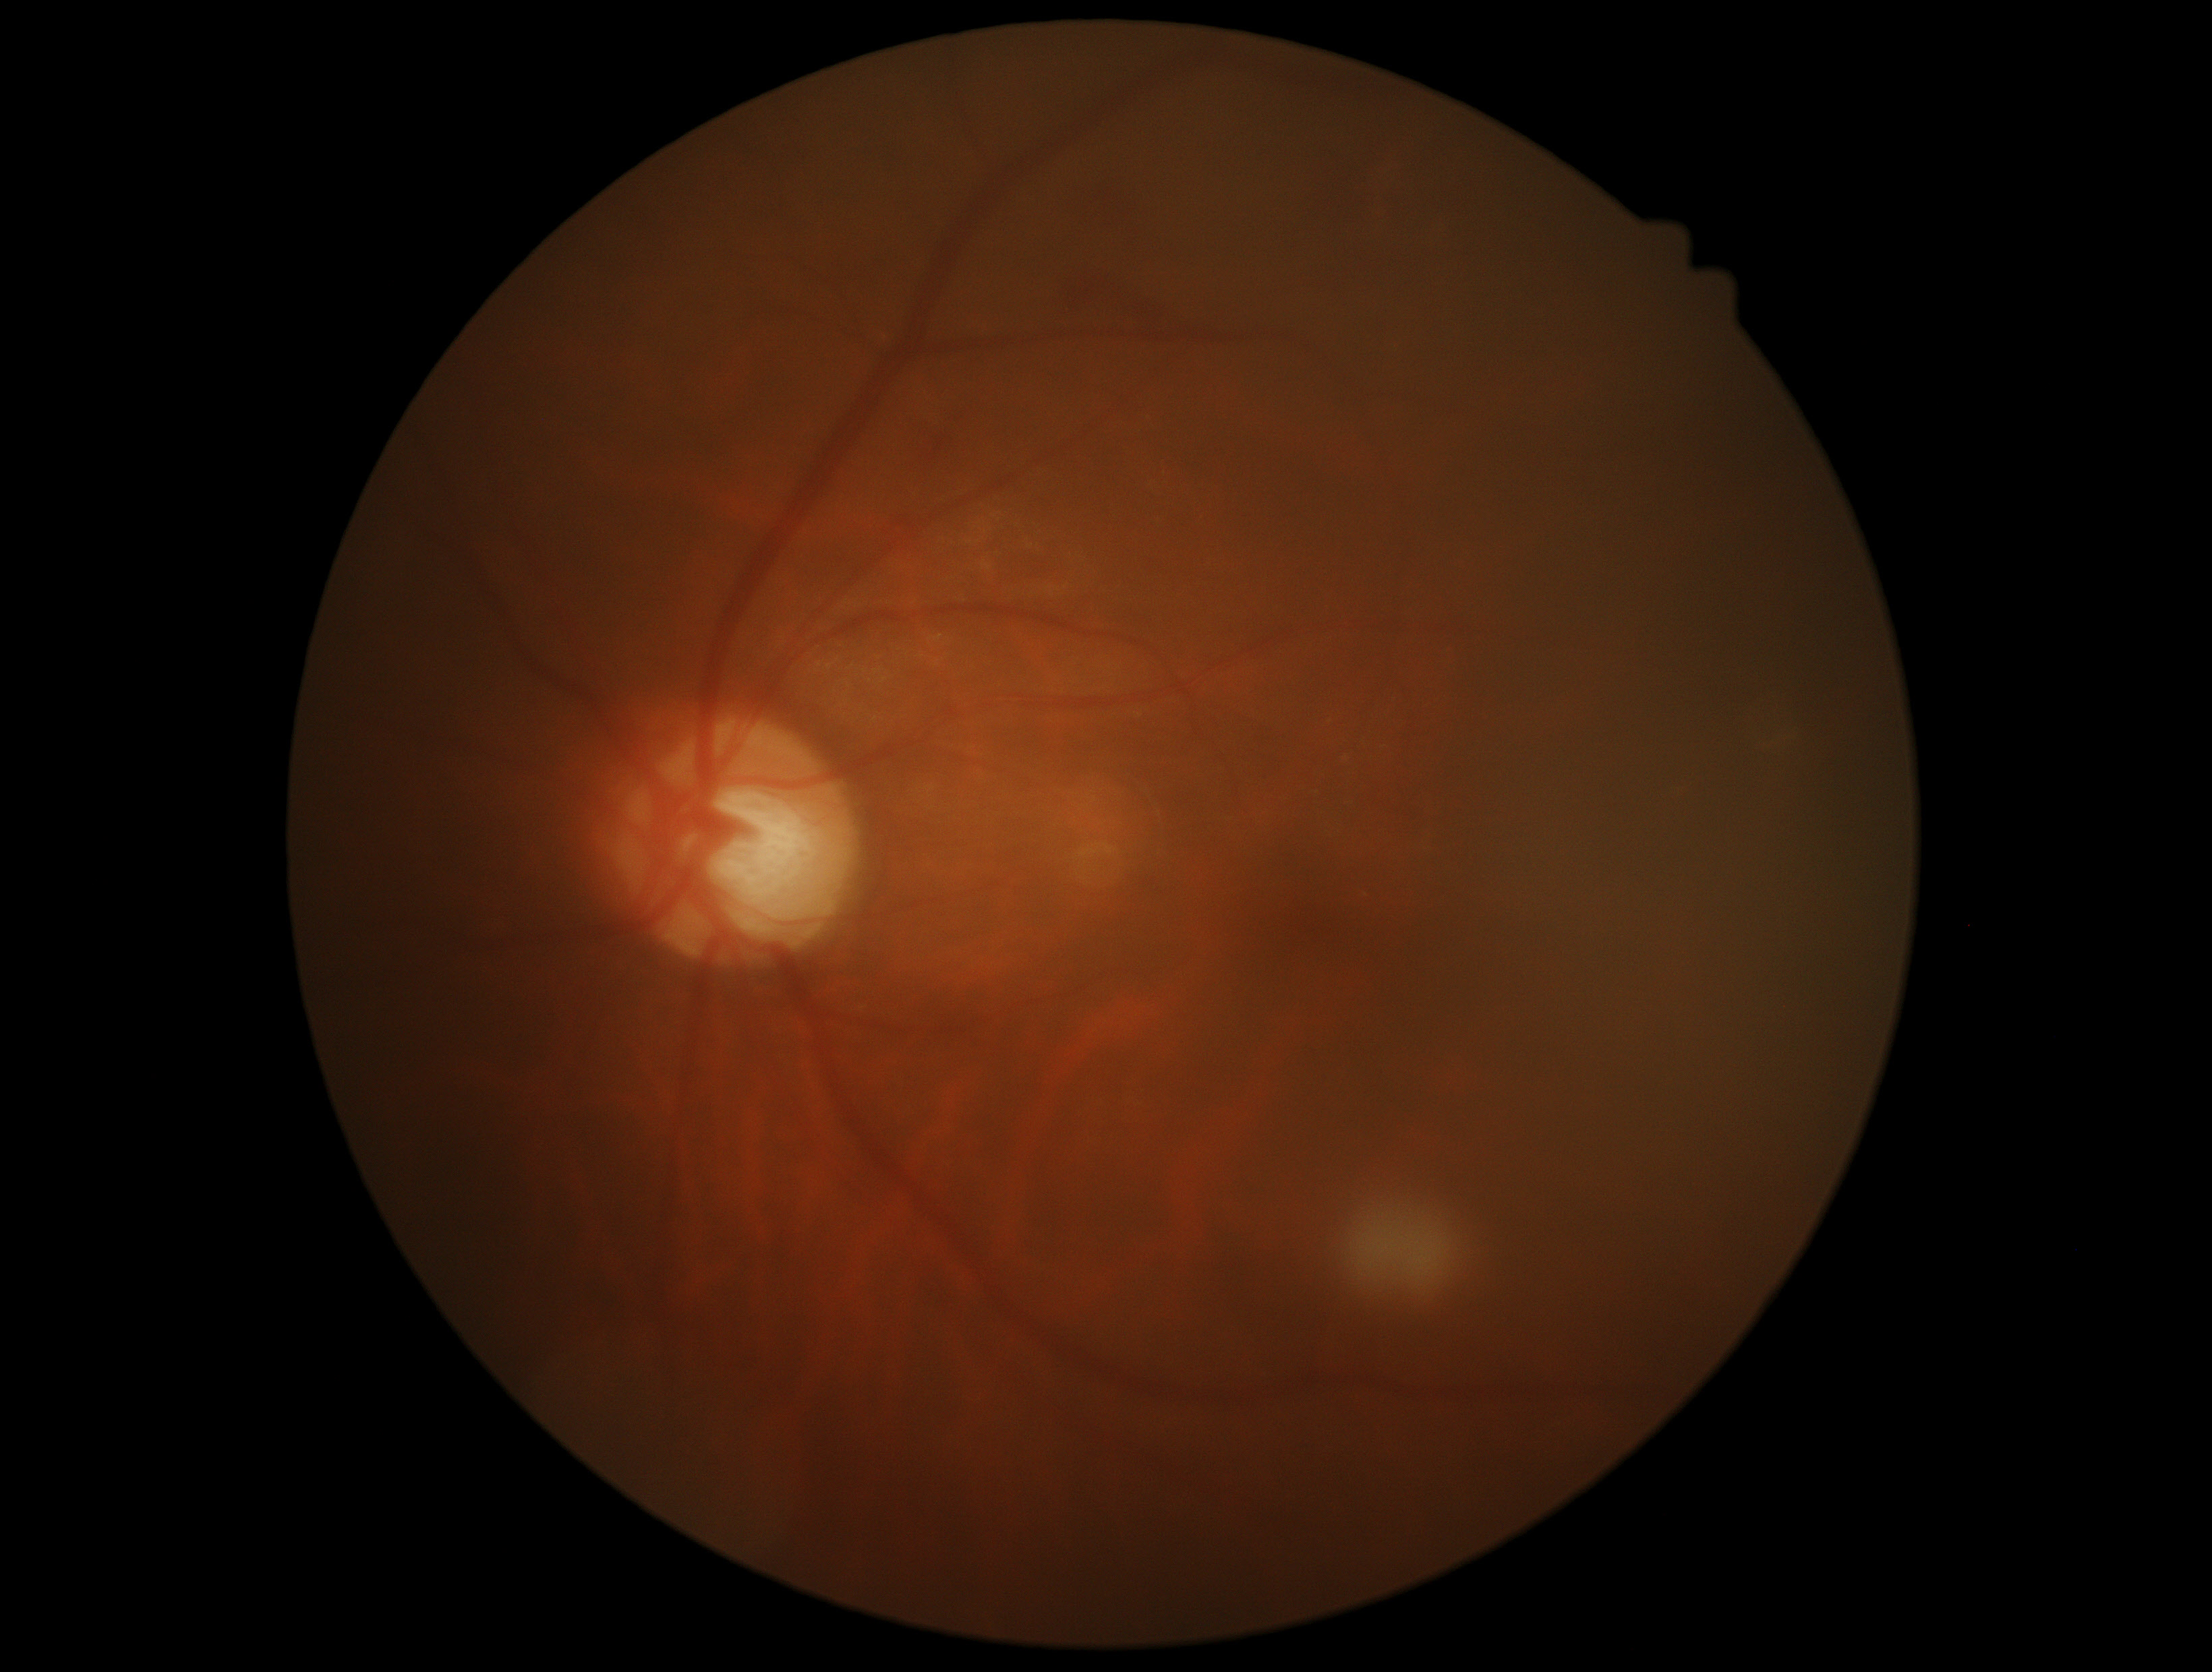 Diabetic retinopathy (DR): grade 2.